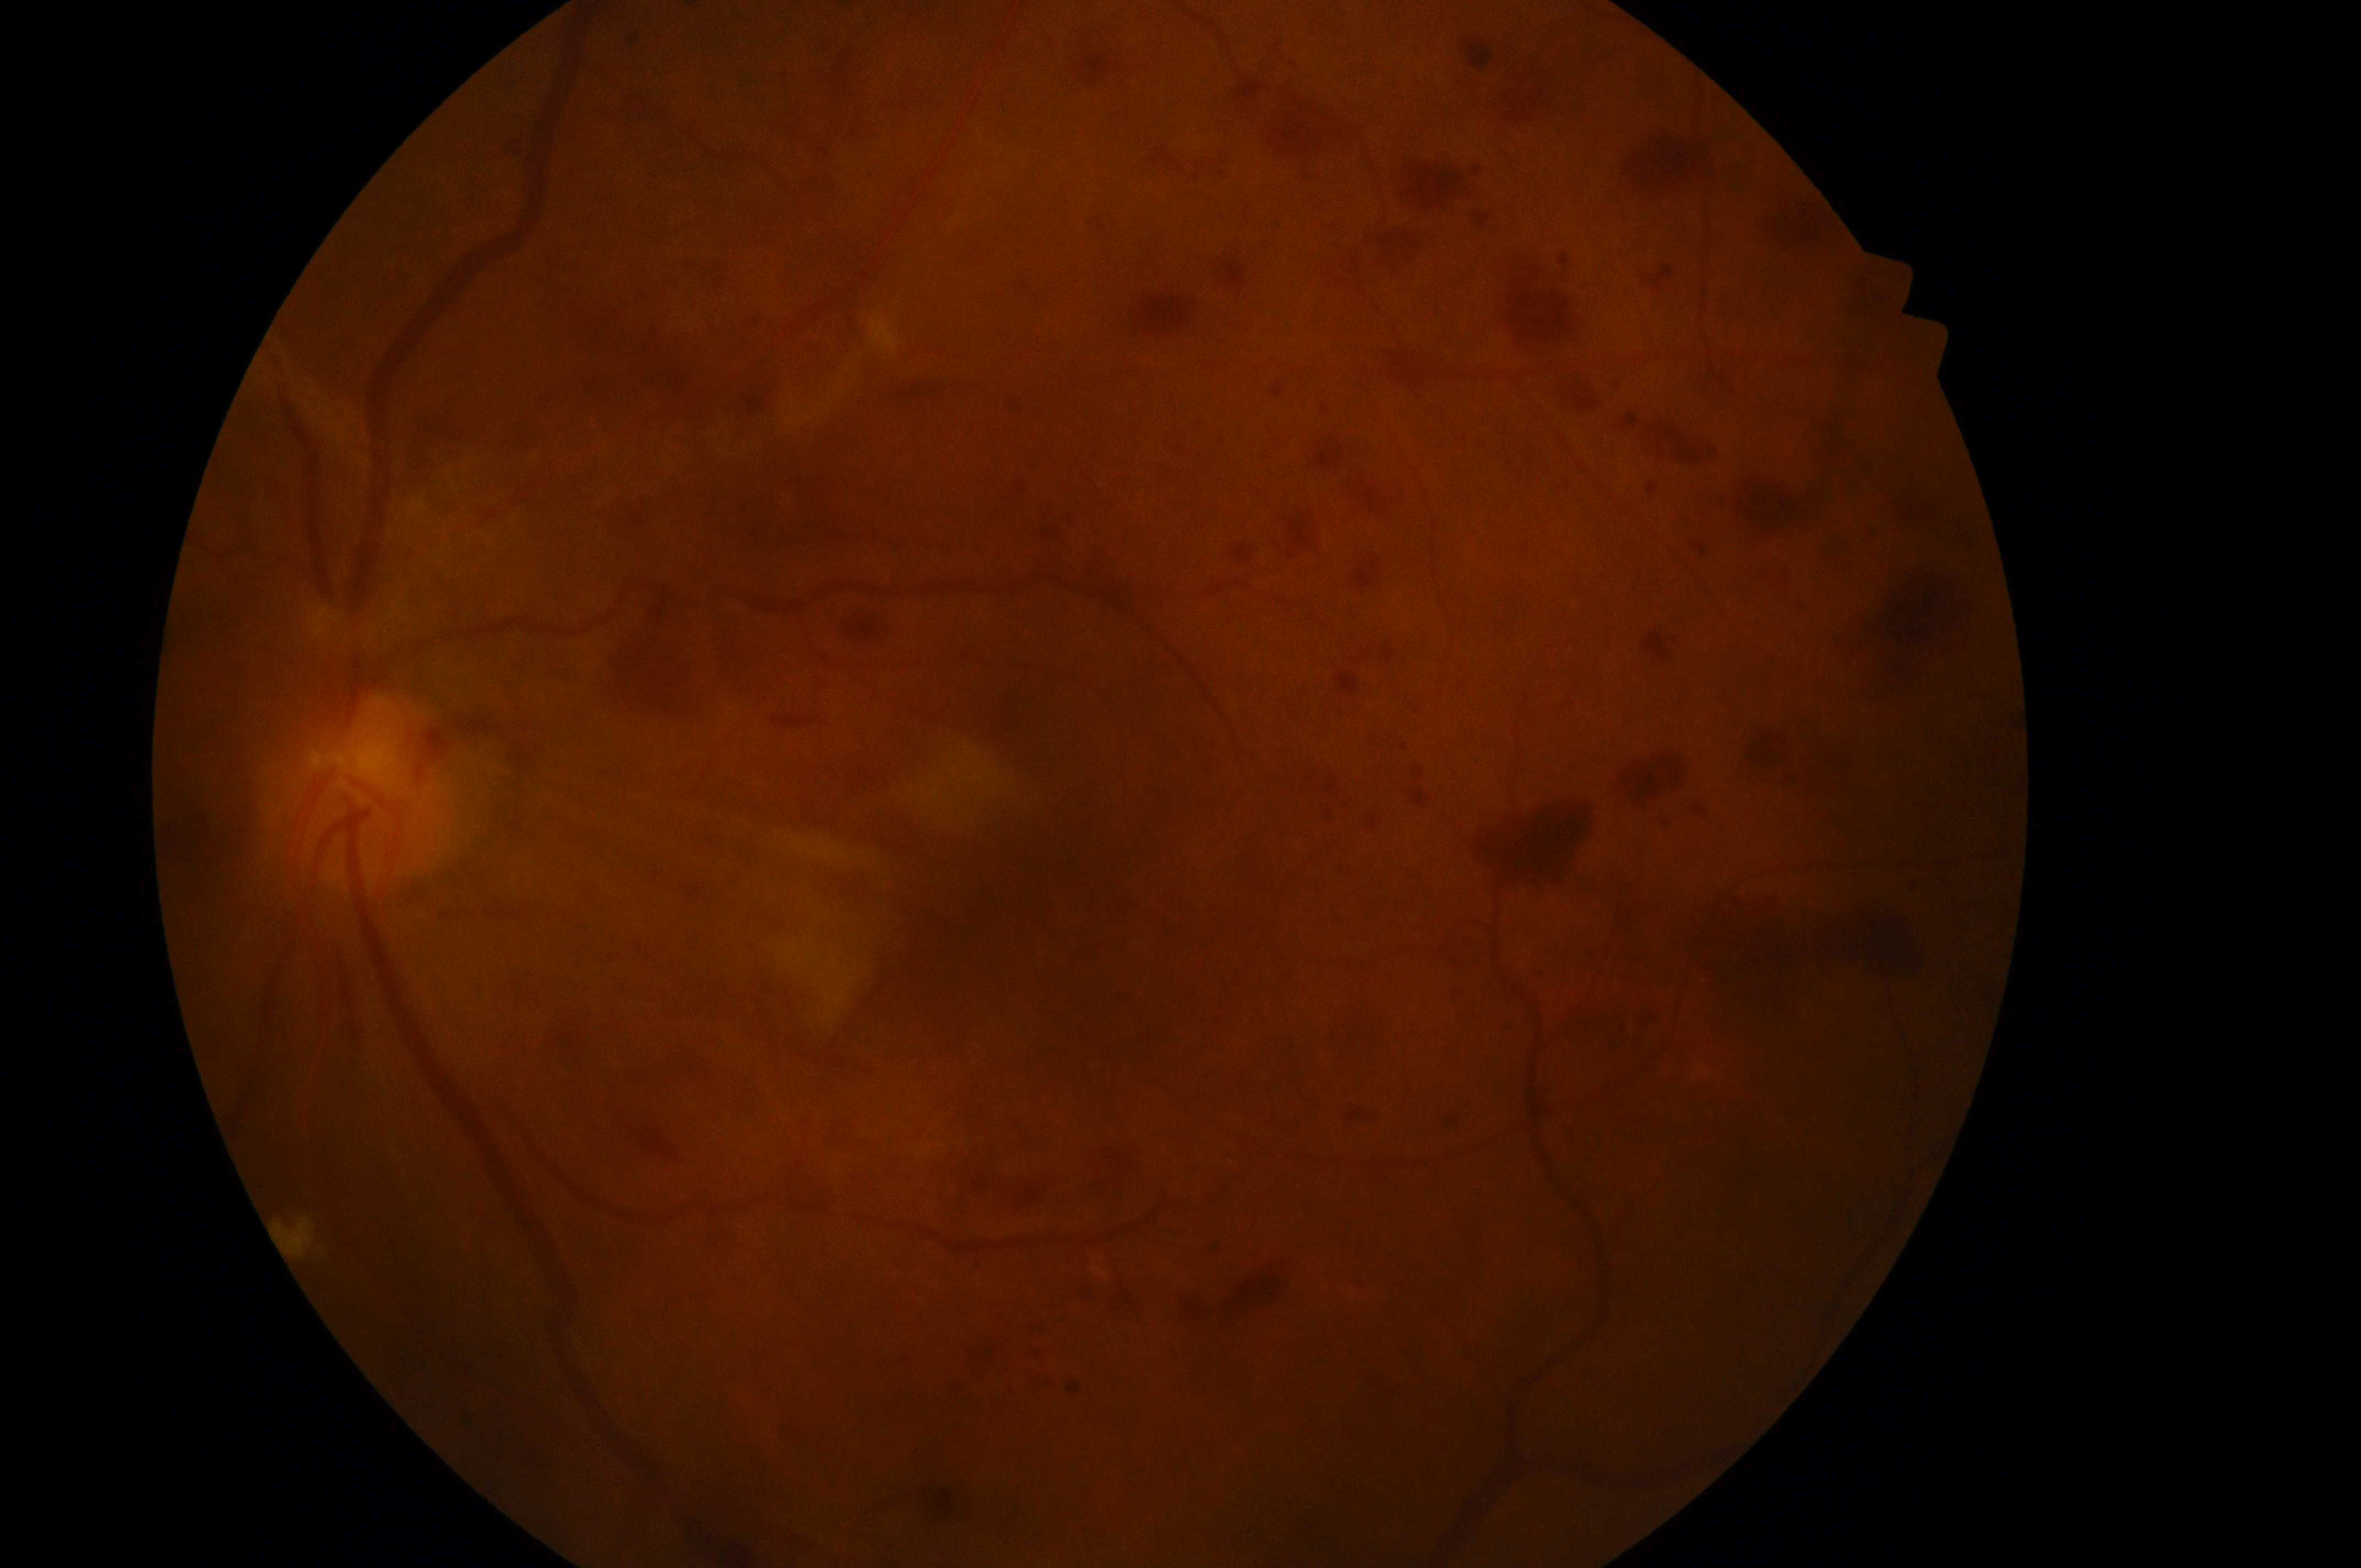
oculus sinister; disc center@358, 800; risk of macular edema@grade 0 (no risk) — no apparent hard exudates; macula center@1054, 890; diabetic retinopathy severity@grade 4 (PDR) — neovascularization and/or vitreous/pre-retinal hemorrhage.